Autorefraction: sphere +4.25 D, cylinder -1.75 D, axis 105° · Topcon TRC-NW400 — 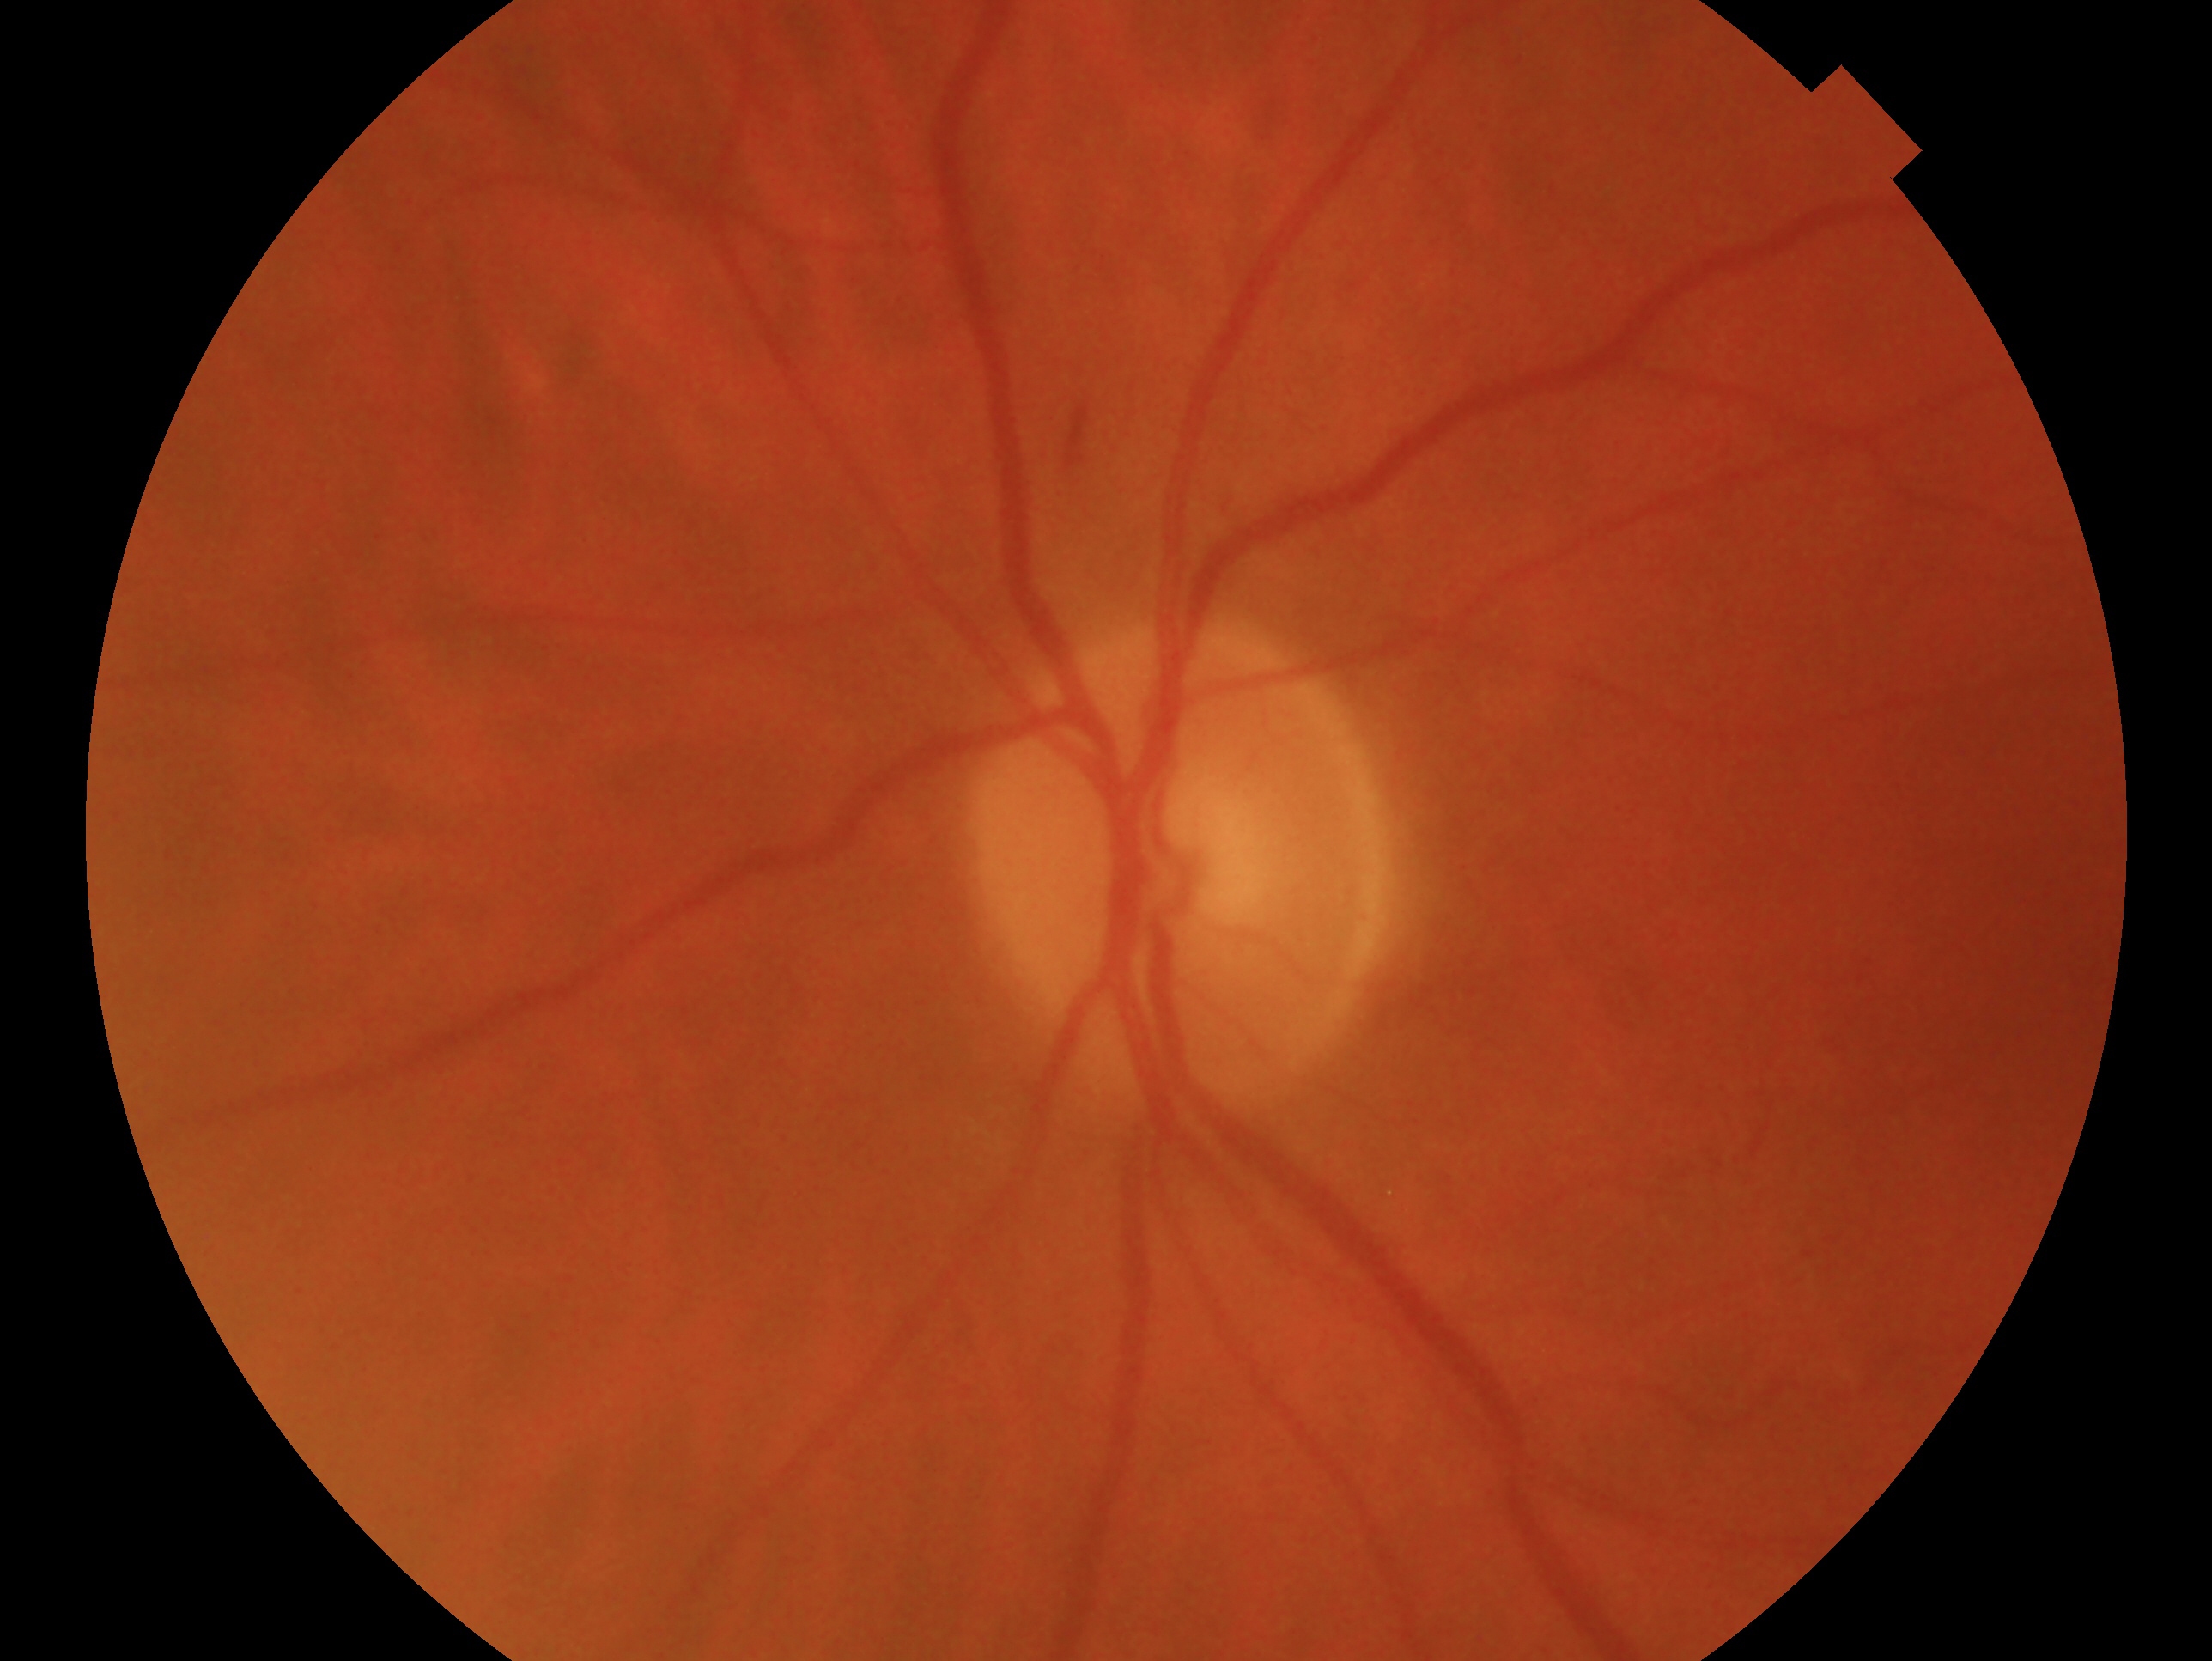

The image shows the left eye. Clinical classification — no signs of glaucoma.